2352x1568: 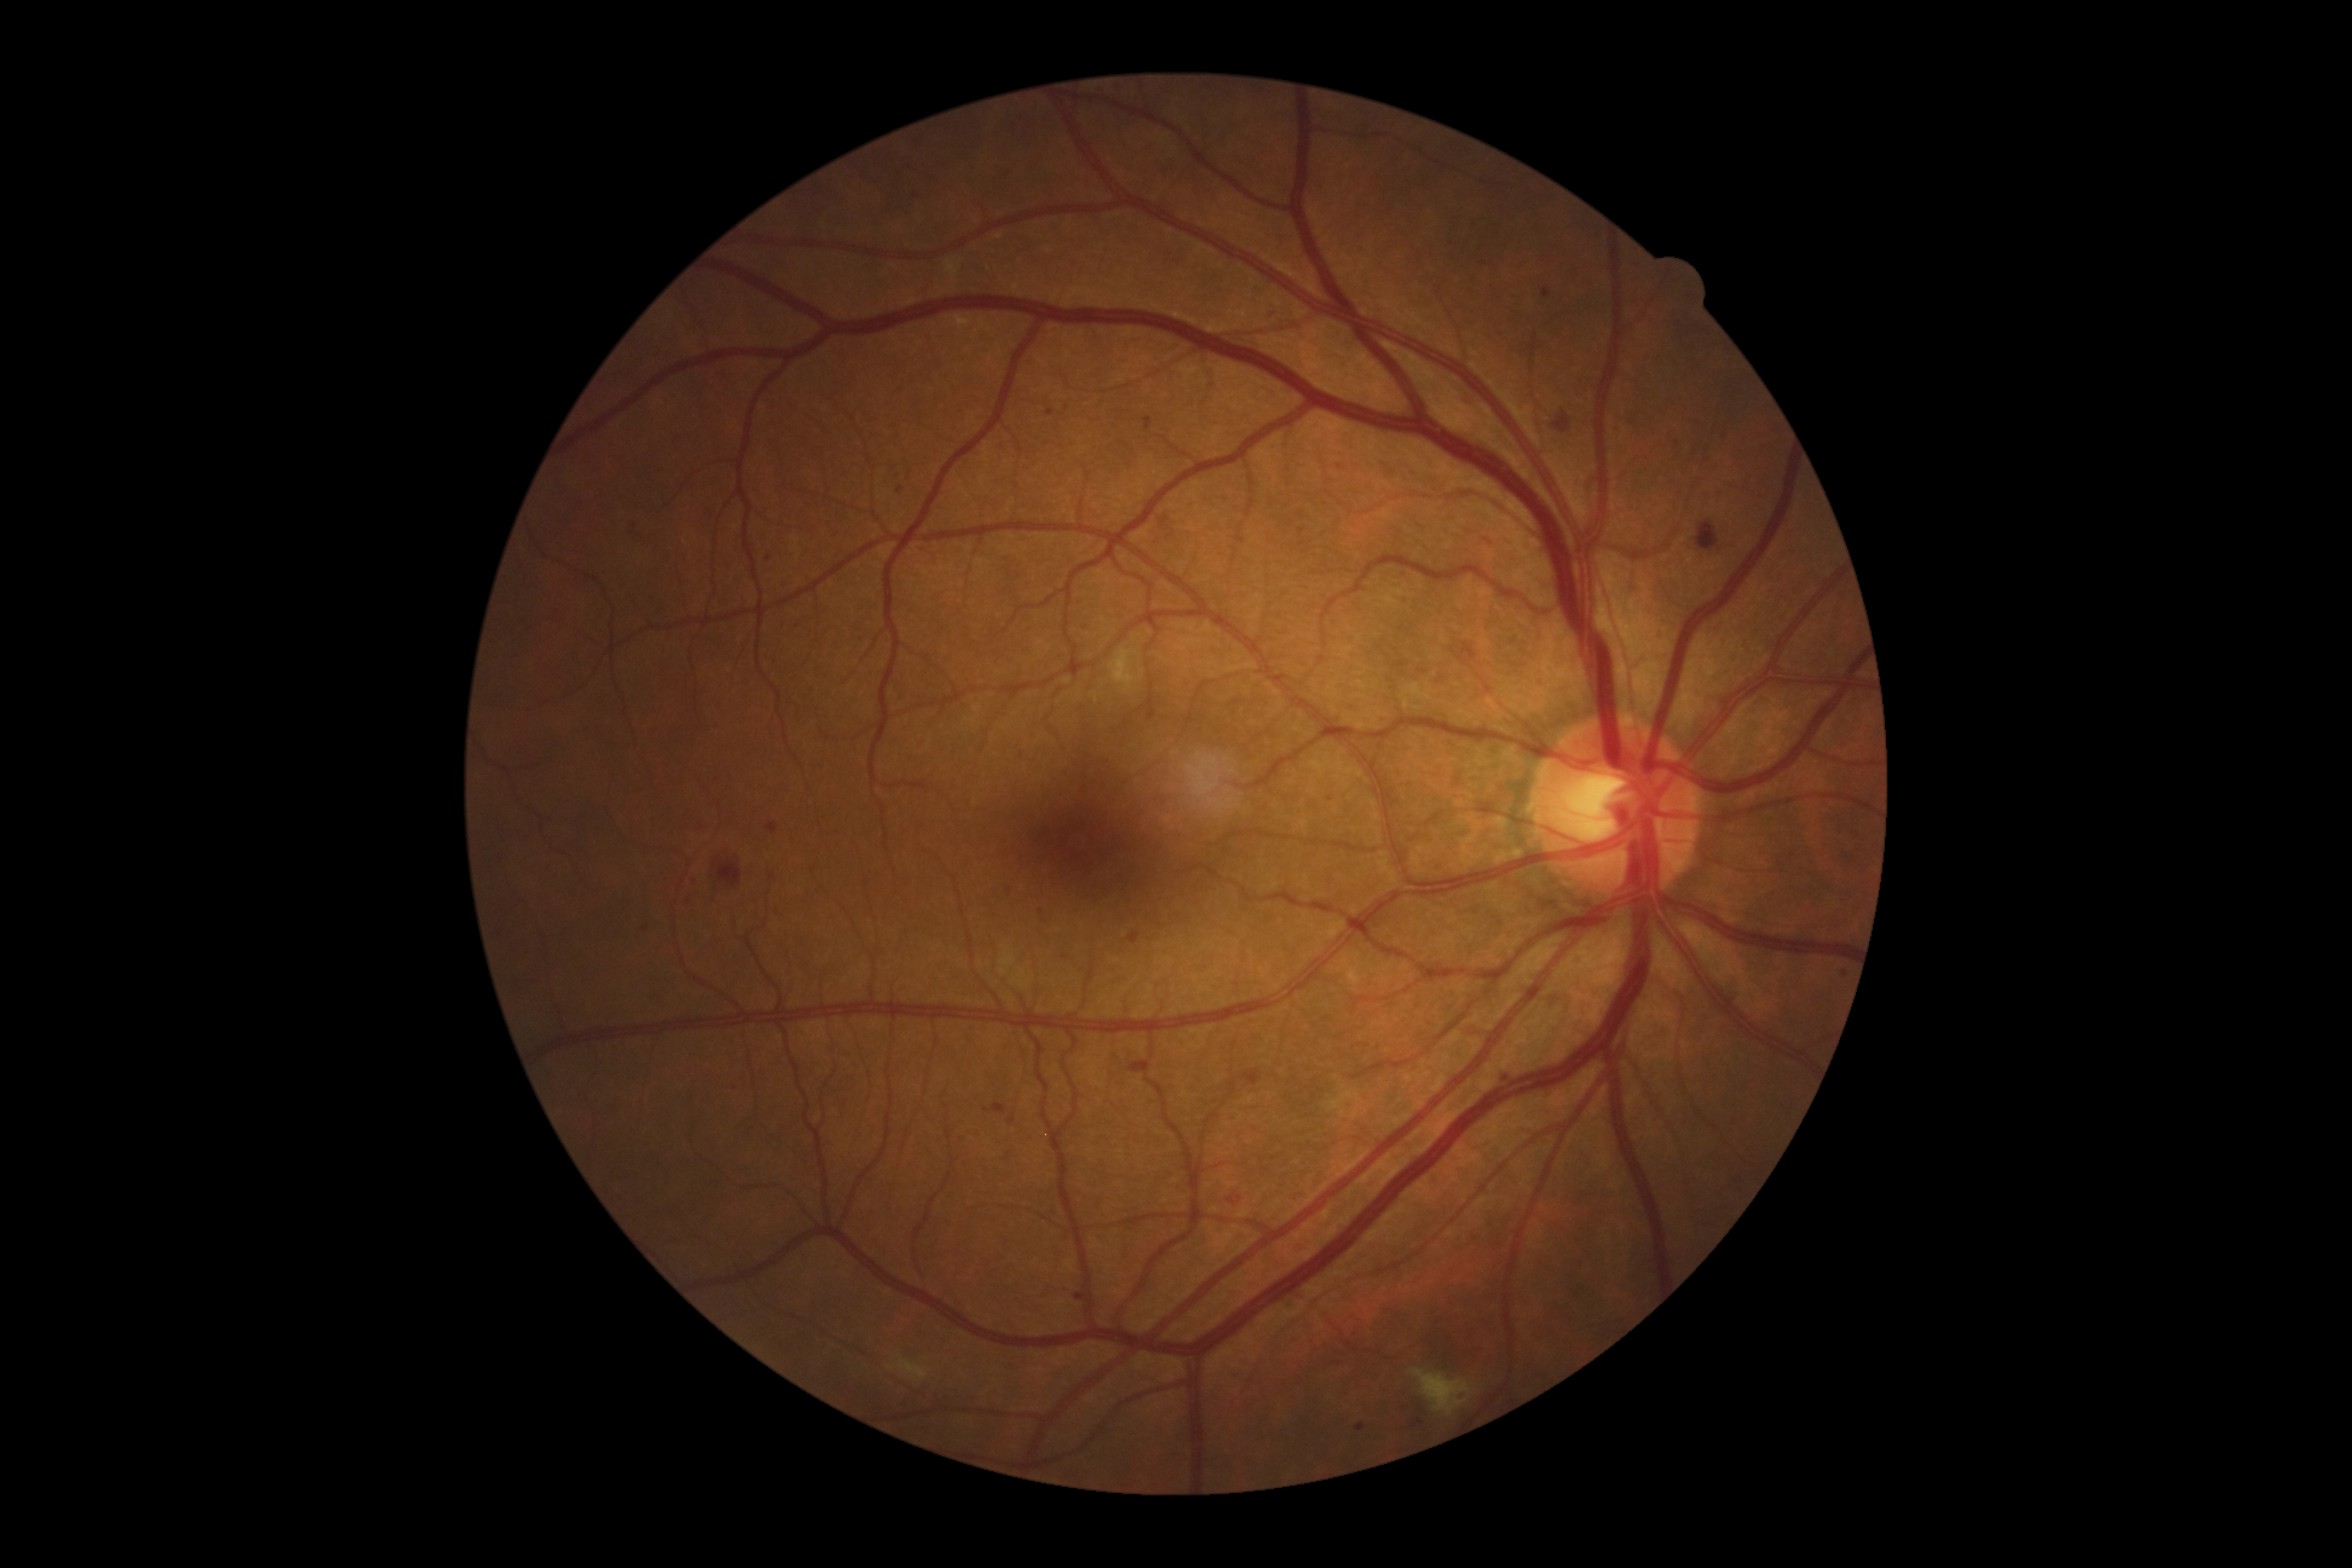
{"partial": true, "dr_grade": 2, "dr_grade_name": "moderate NPDR", "lesions": {"ma": [[1543, 289, 1552, 298], [766, 823, 779, 835], [711, 723, 720, 728], [683, 895, 695, 903], [1498, 1076, 1507, 1082], [688, 874, 696, 884], [1046, 410, 1054, 417]], "ma_small_approx": [[1302, 530], [1065, 957], [634, 525], [1707, 460], [913, 196], [1725, 432], [664, 873], [1341, 467], [899, 490], [1042, 911]]}}